1932x1932px.
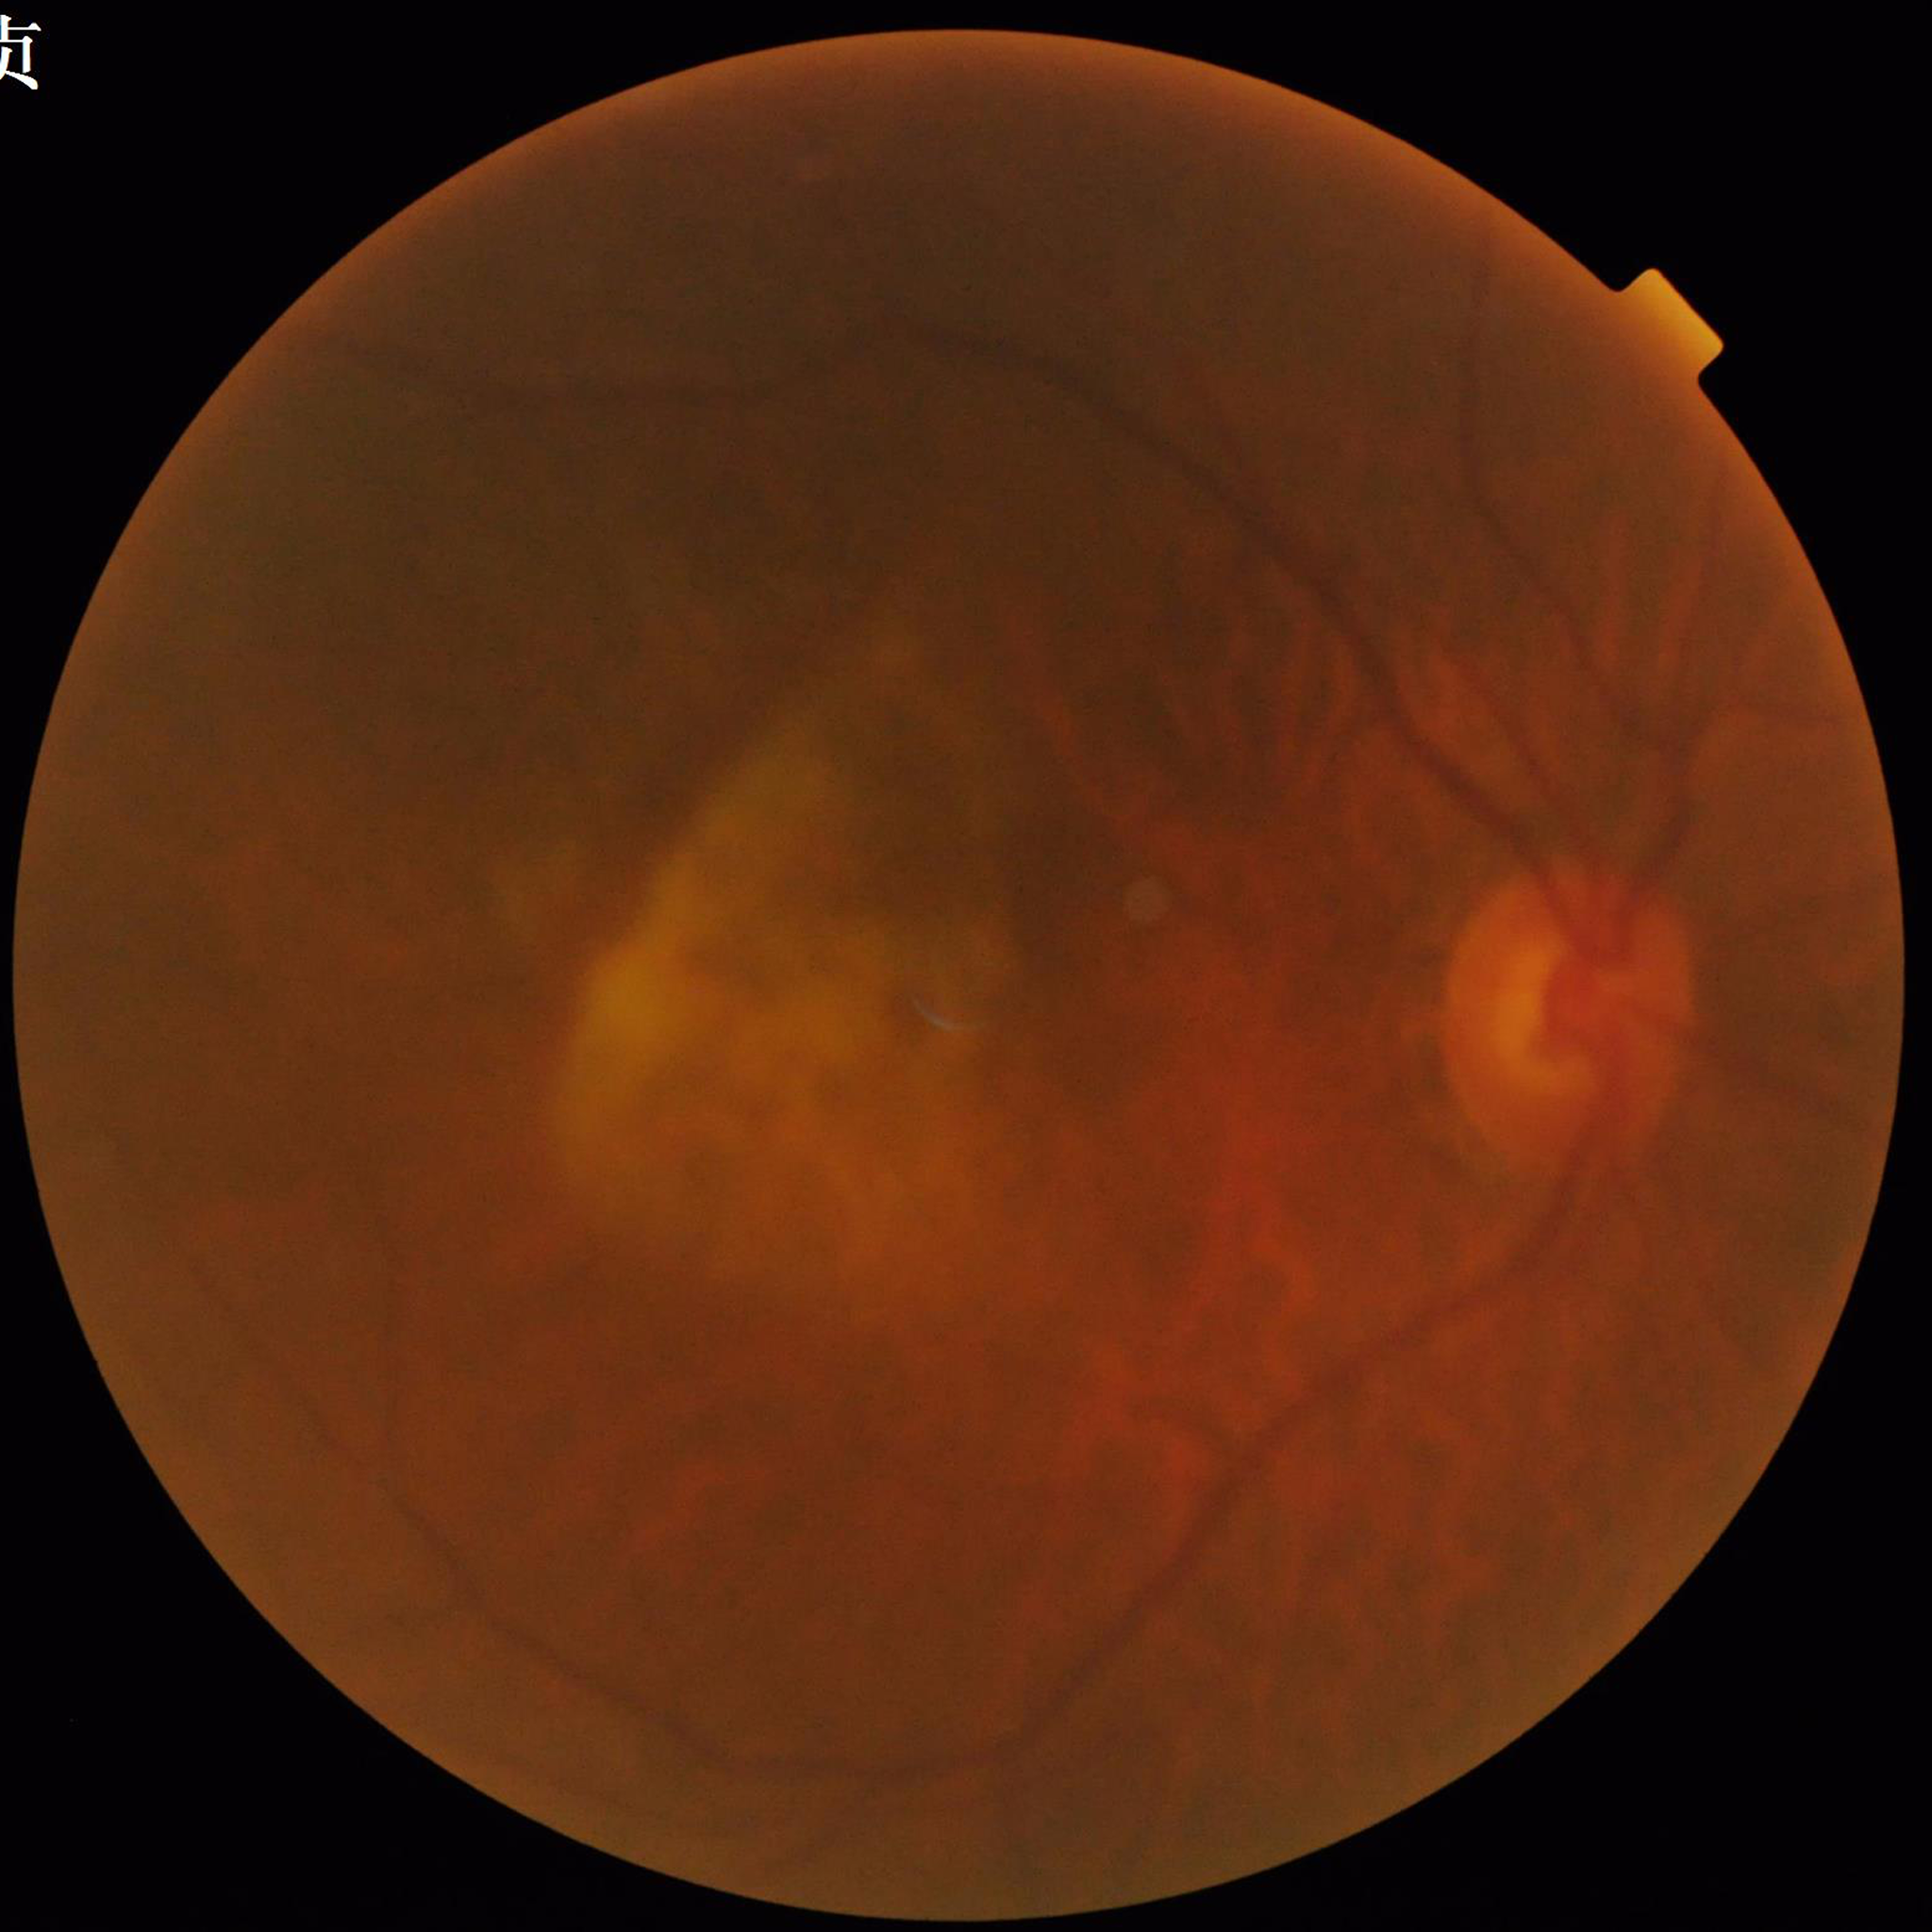
Color fundus photo. Patient diagnosed with age-related macular degeneration. Automated quality assessment: concerns include blur.